FOV: 45 degrees, modified Davis classification: 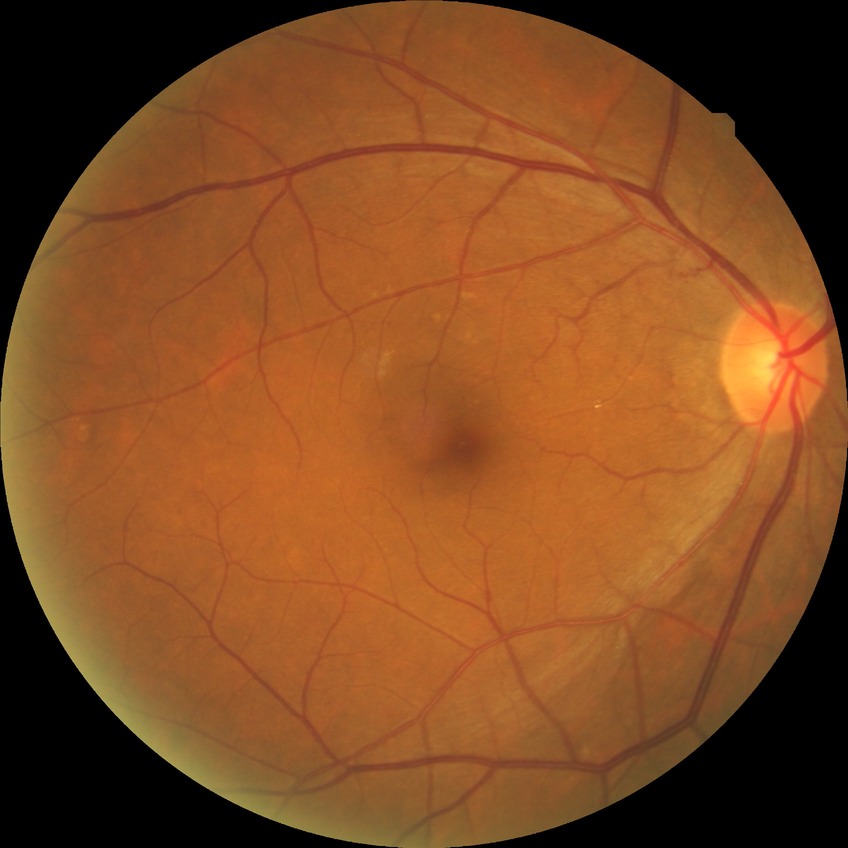
diabetic retinopathy (DR)@no diabetic retinopathy (NDR).